240 by 240 pixels
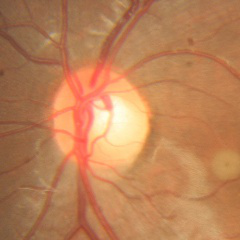
No glaucomatous findings.